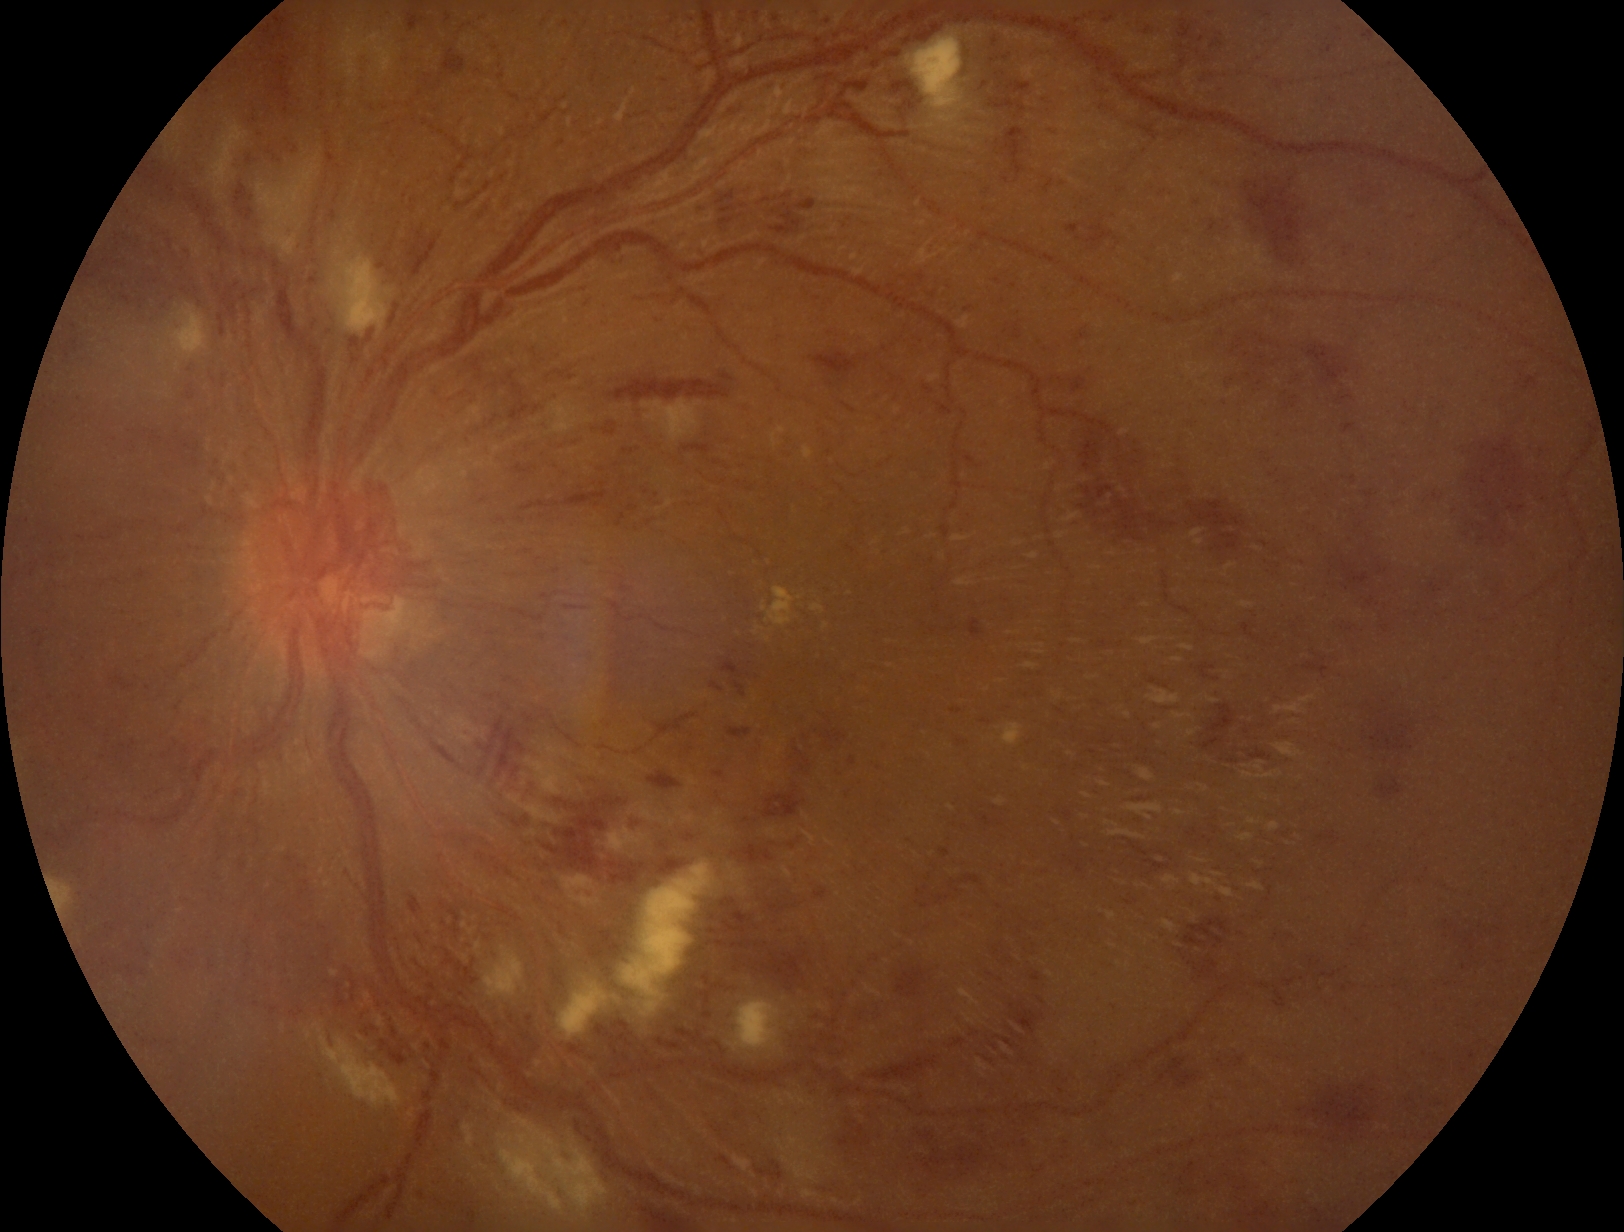
Findings:
* diabetic retinopathy grade: 4 (PDR)